Wide-field contact fundus photograph of an infant; acquired on the Phoenix ICON: 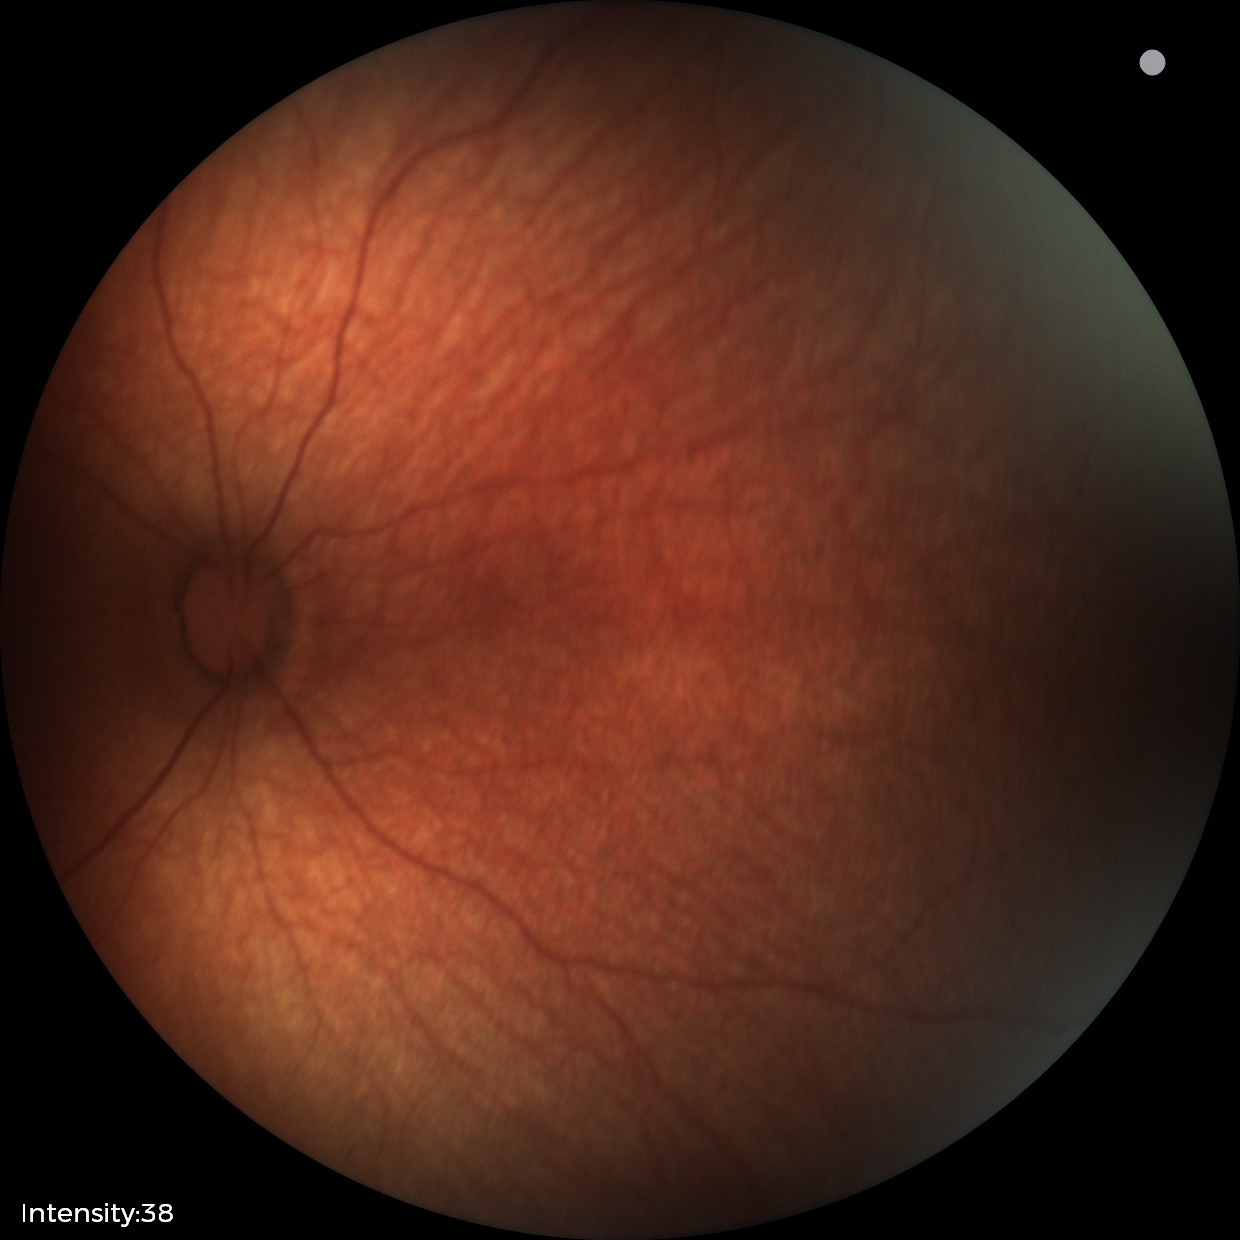 Normal screening examination.